Camera: Topcon TRC-50DX:
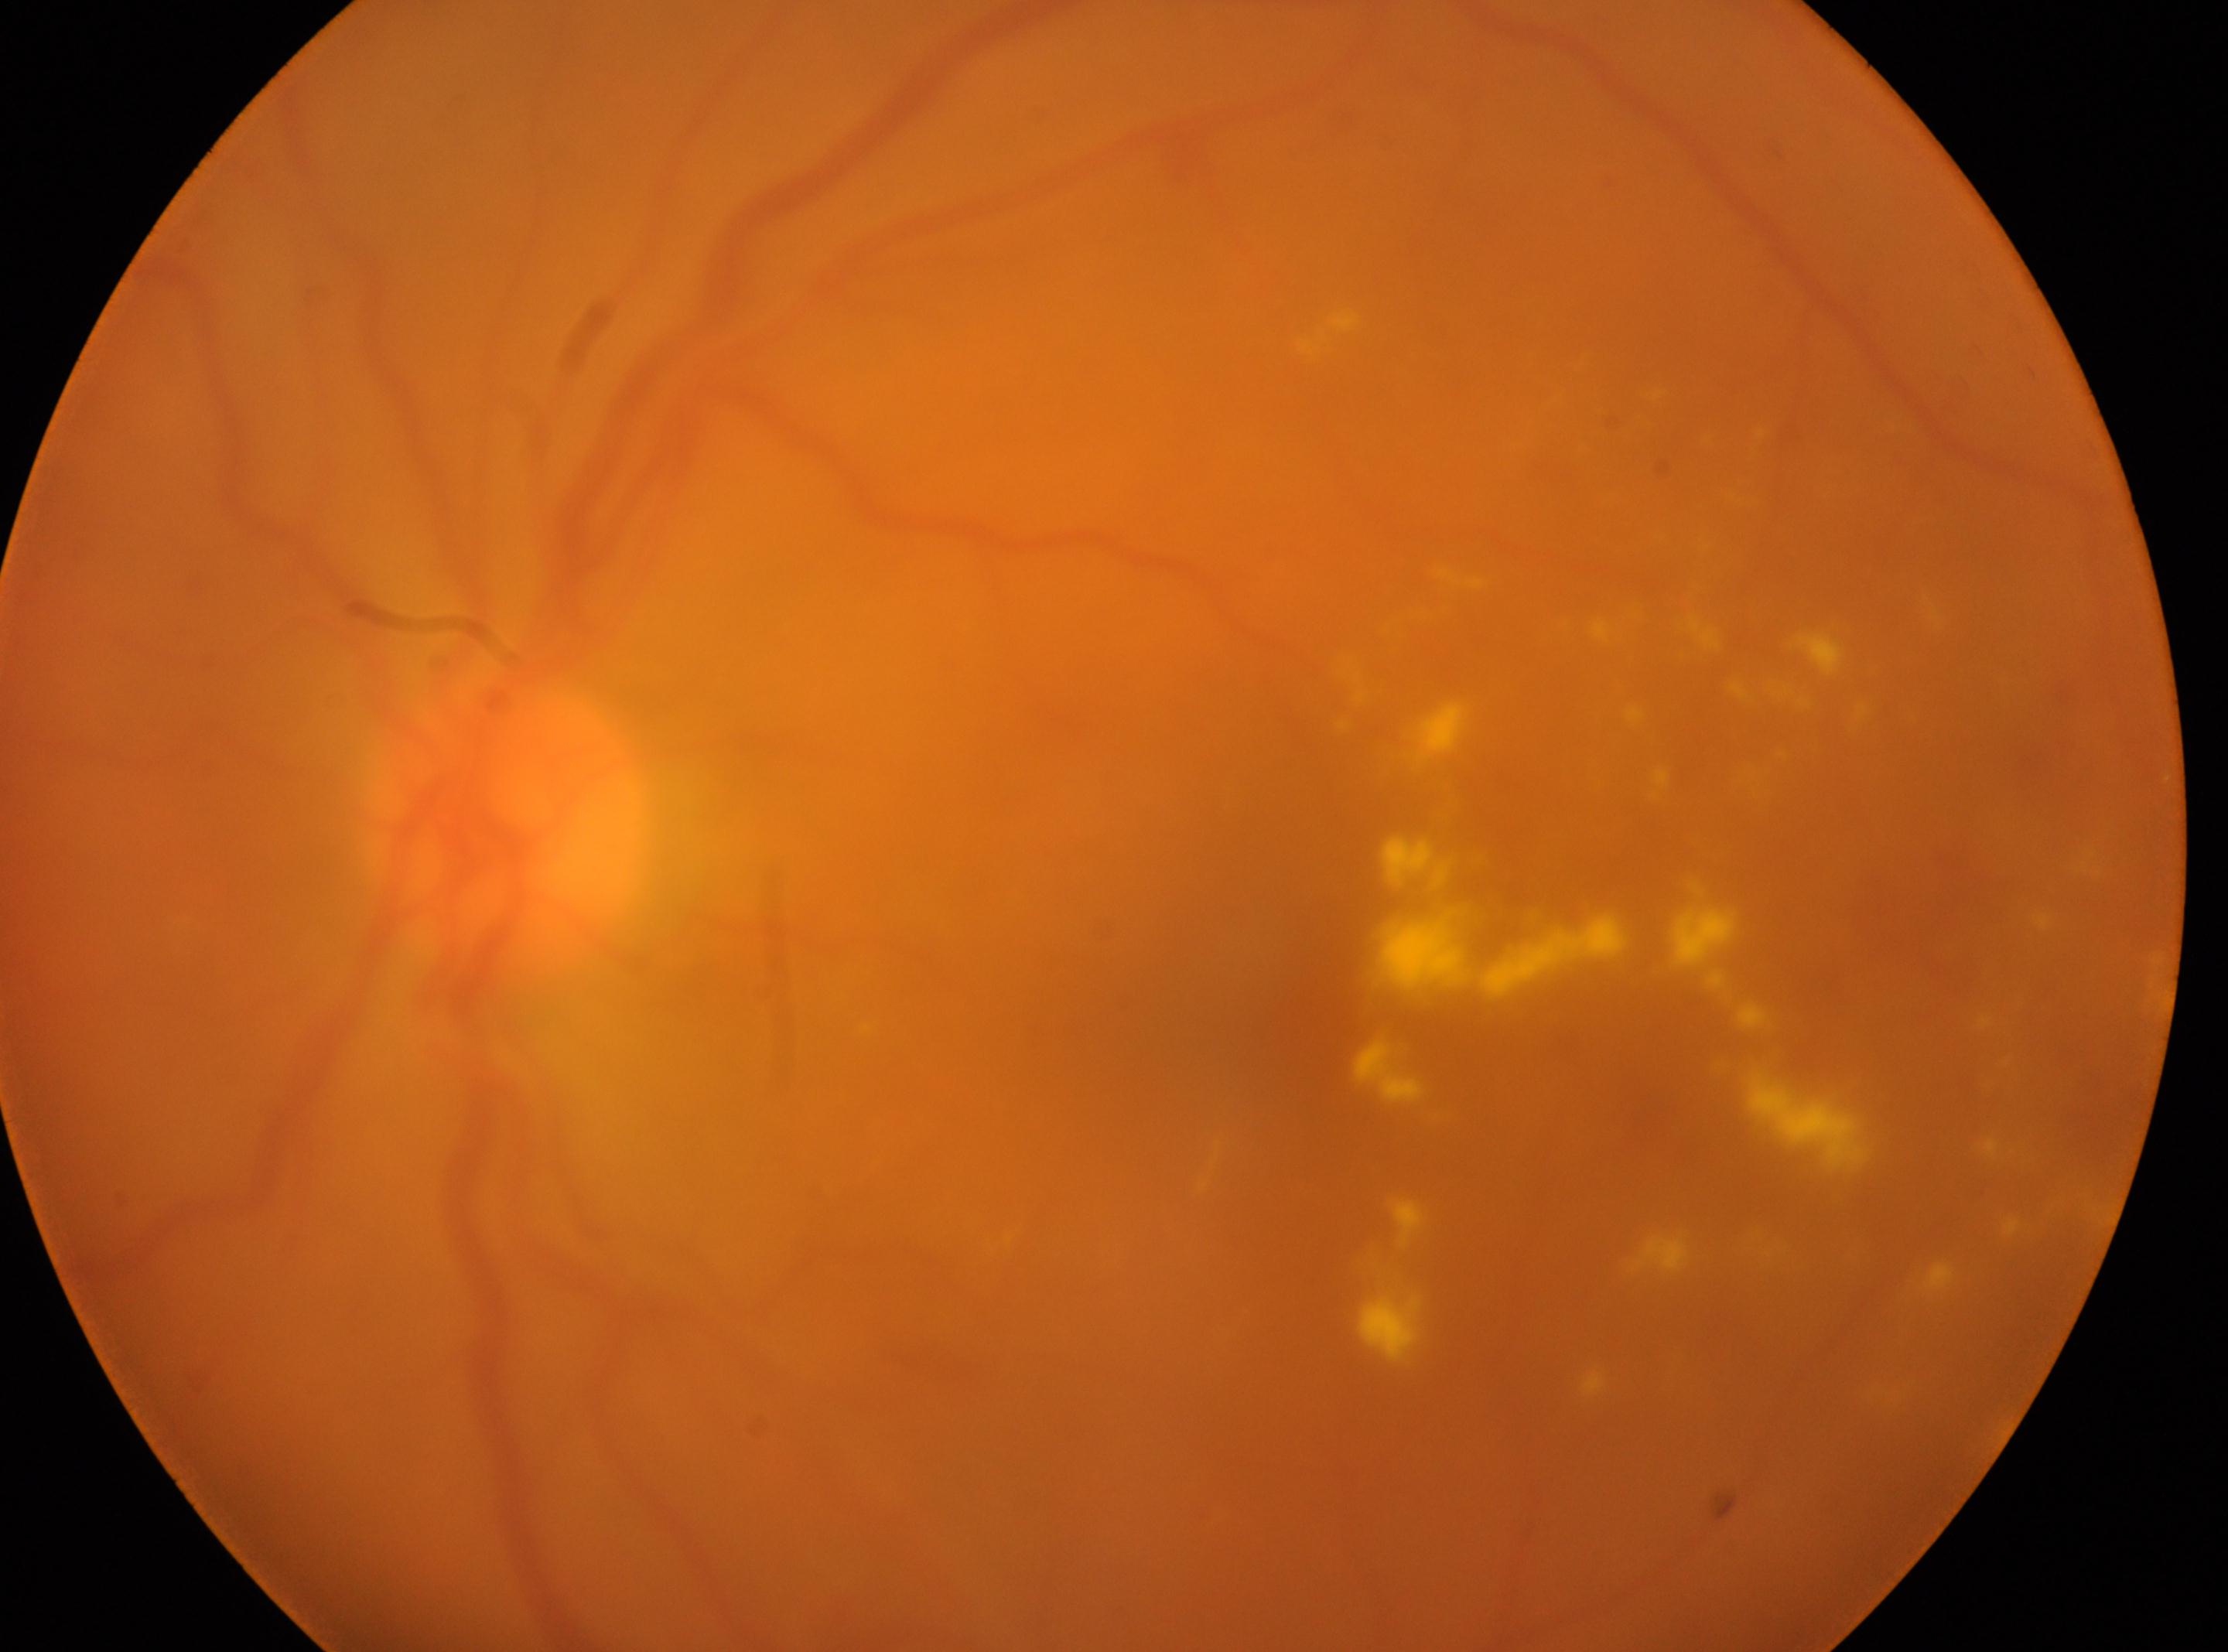
{"fovea": "1253px, 1009px", "eye": "left eye", "dr_category": "non-proliferative diabetic retinopathy", "dr_grade": "2 (moderate NPDR)", "optic_disc": "504px, 828px"}